240 by 240 pixels: 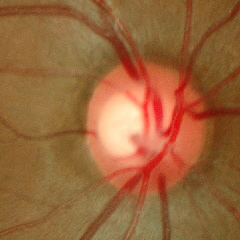 Color fundus photograph showing early glaucoma.